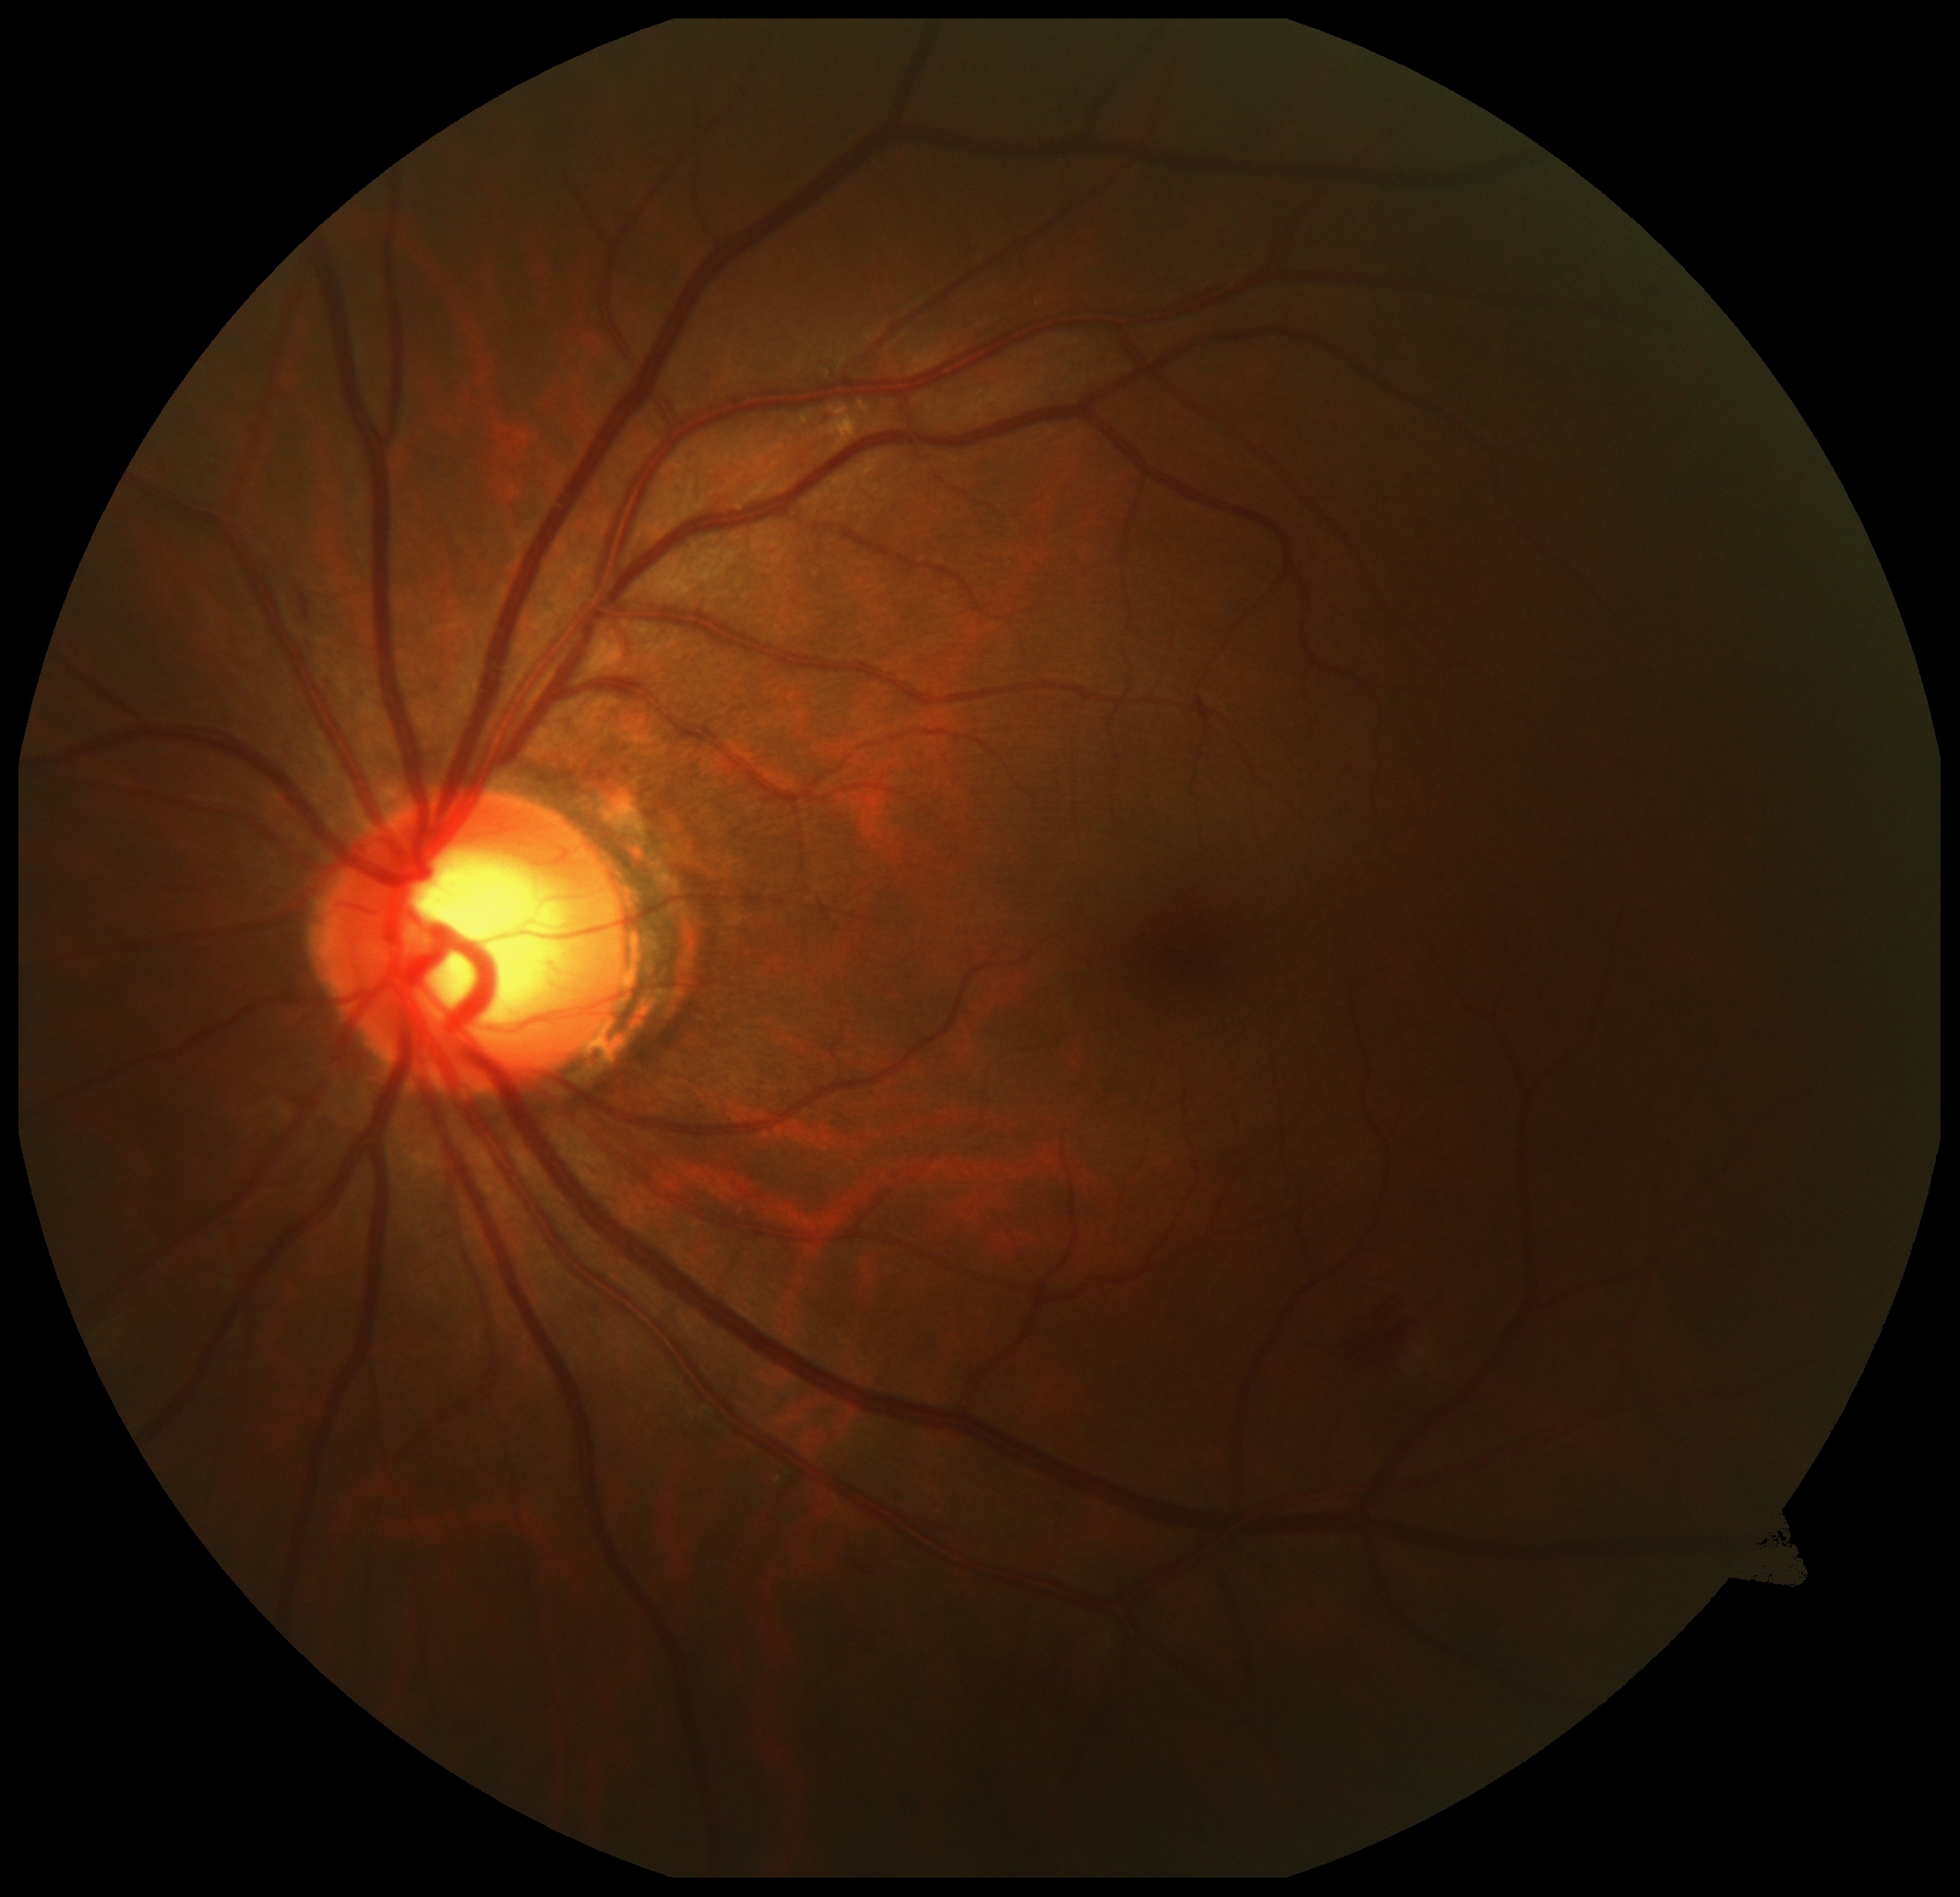

DR grade: 2.